2048 x 1536 pixels: 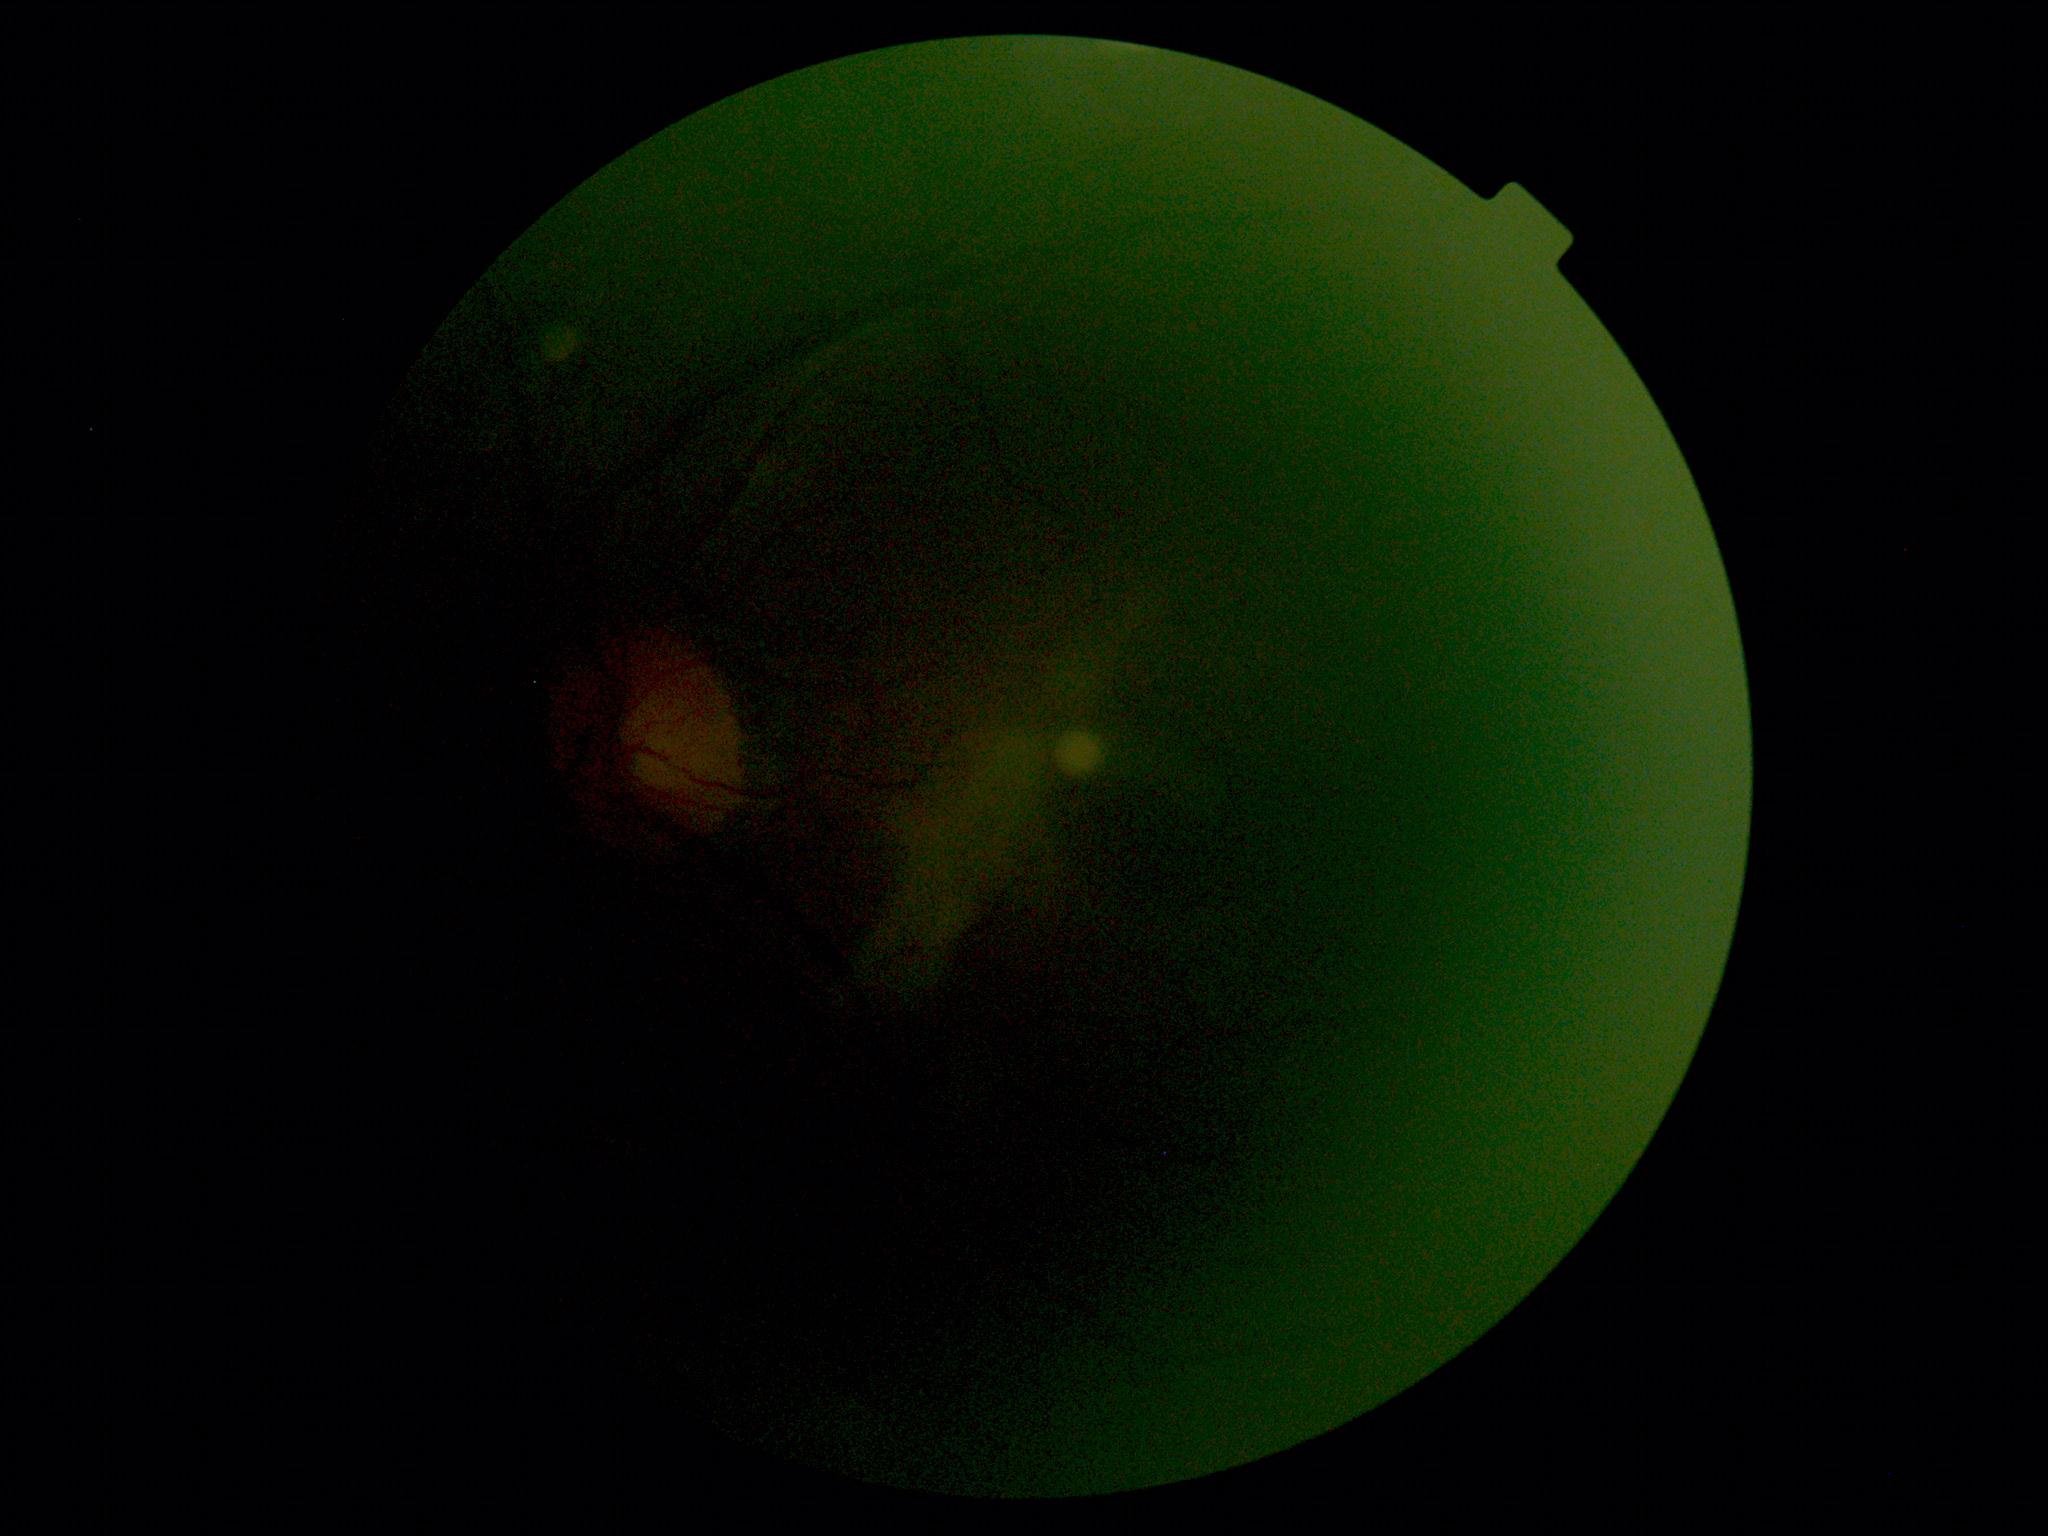
image quality@below grading threshold; DR severity@ungradable.